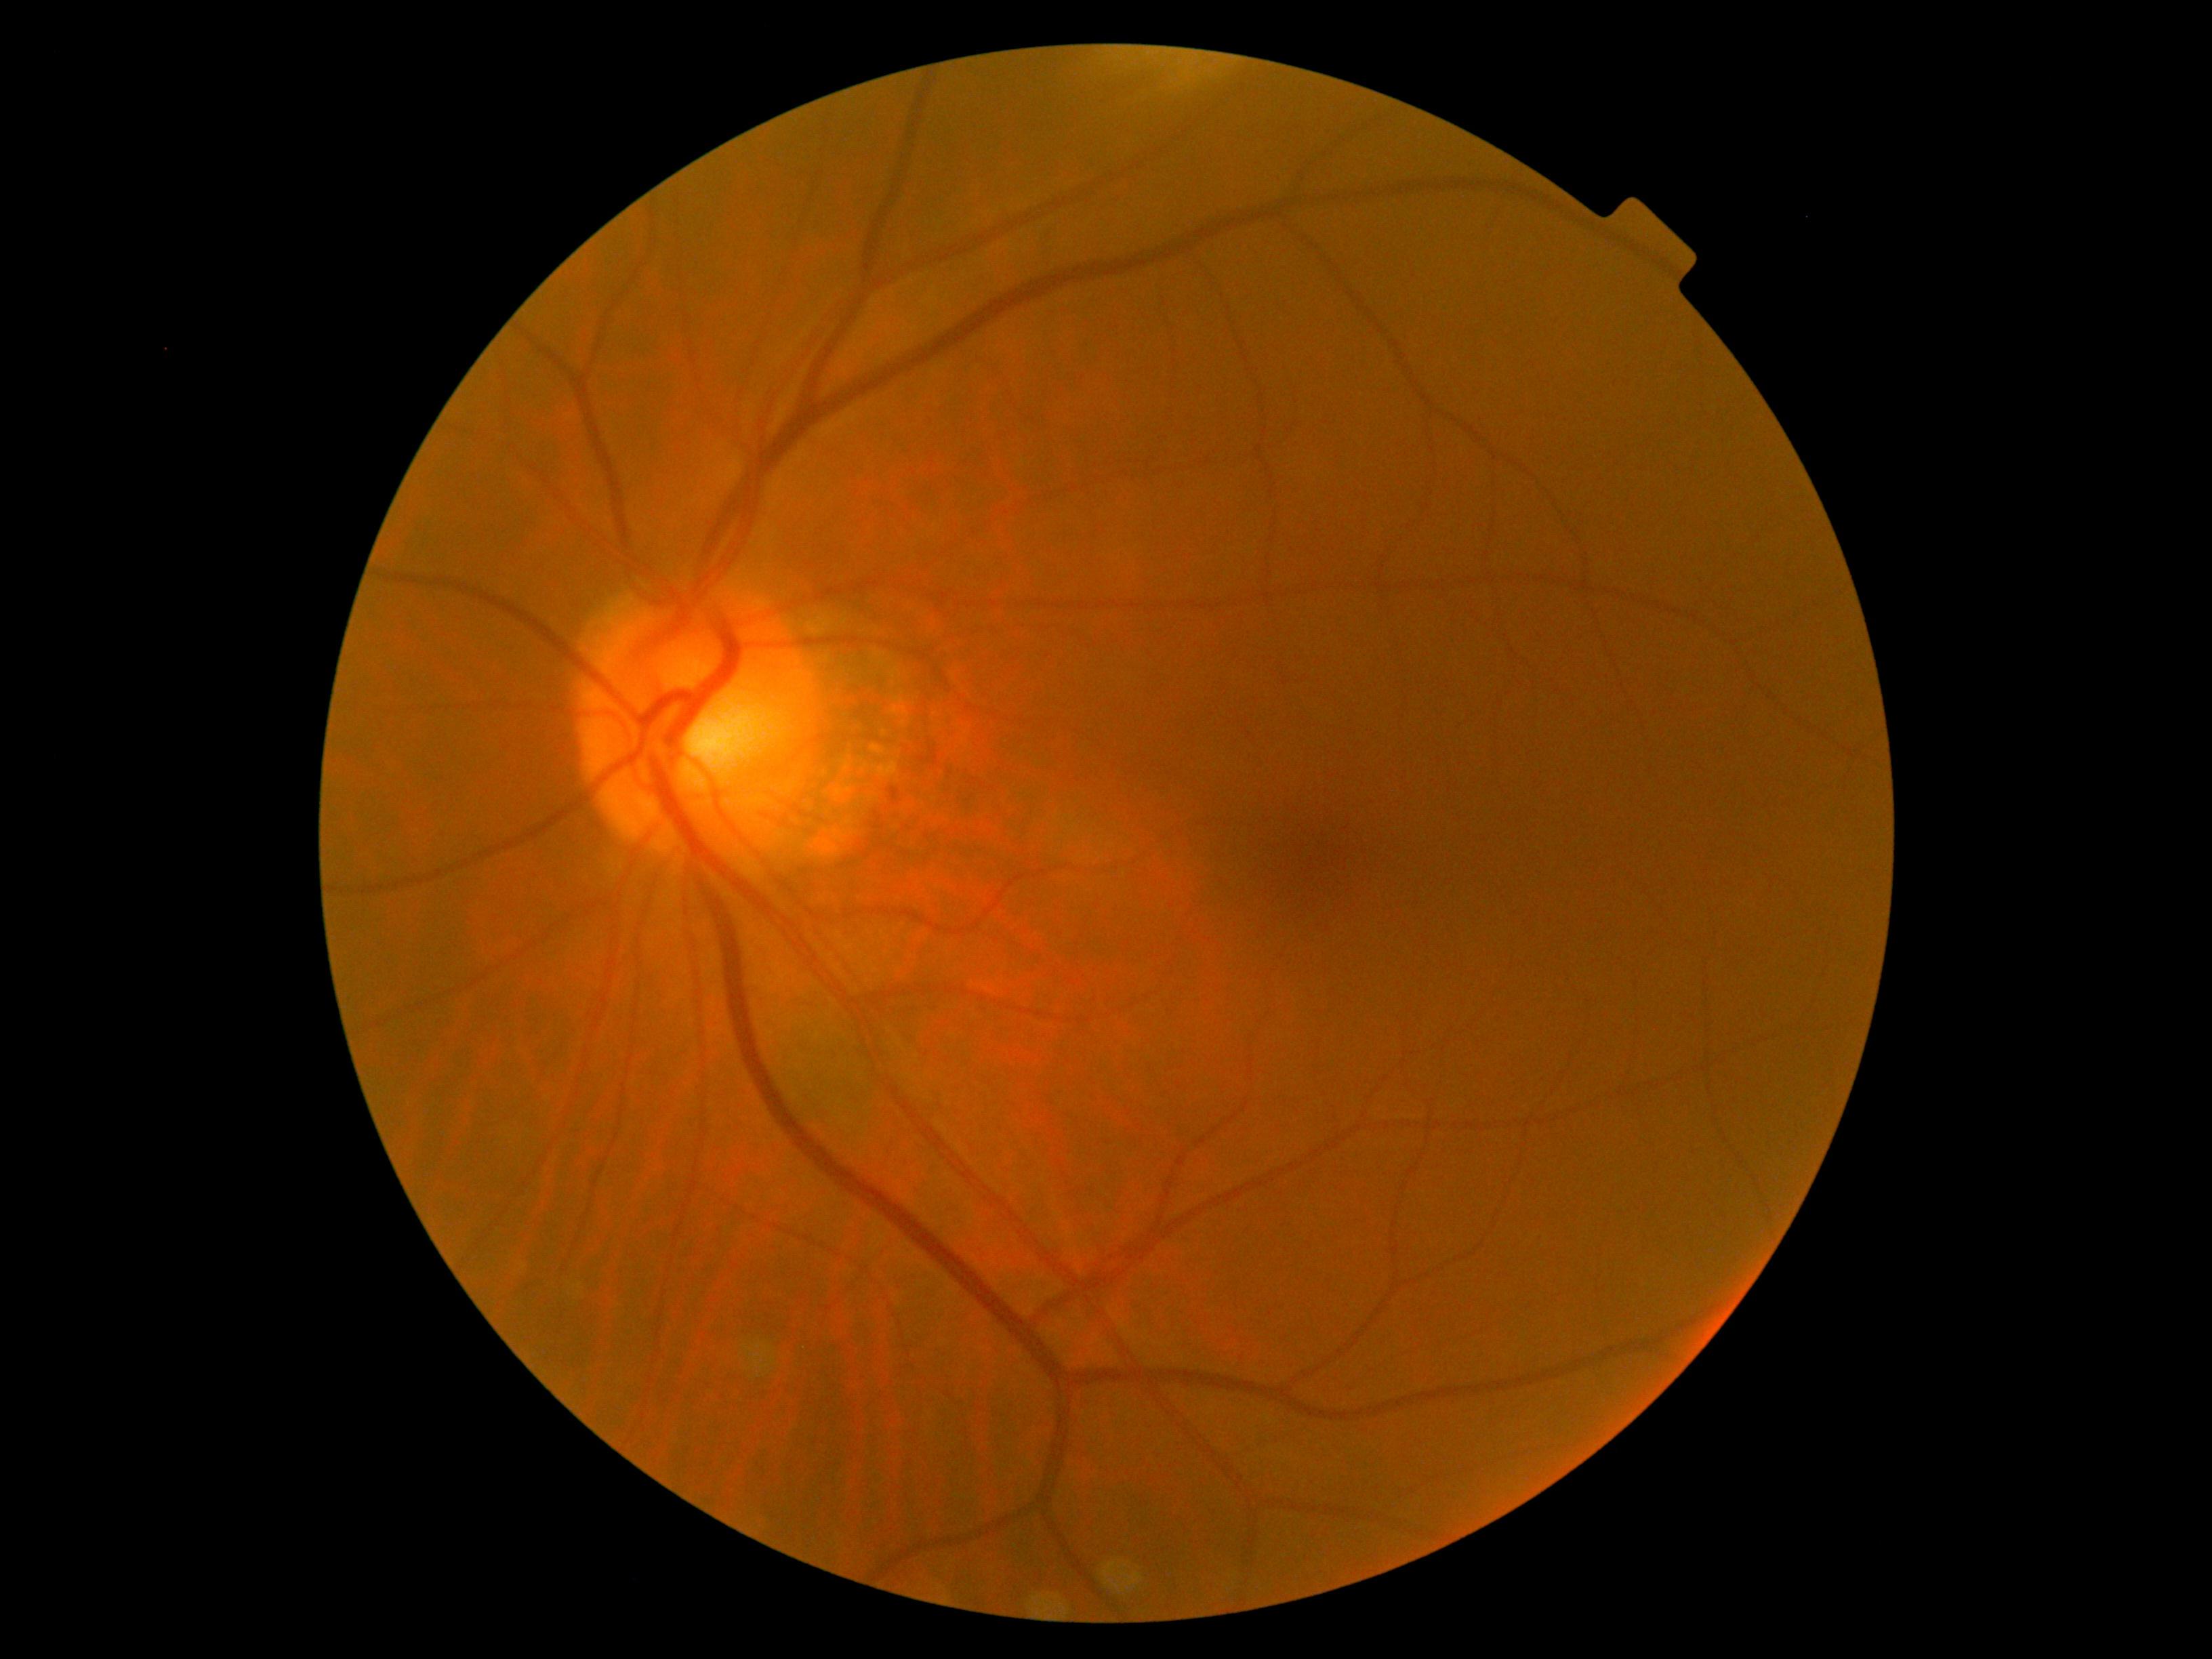
DR impression: no apparent DR | retinopathy grade: no apparent diabetic retinopathy (0).